Retinal fundus photograph, 2212x1659, 45-degree field of view — 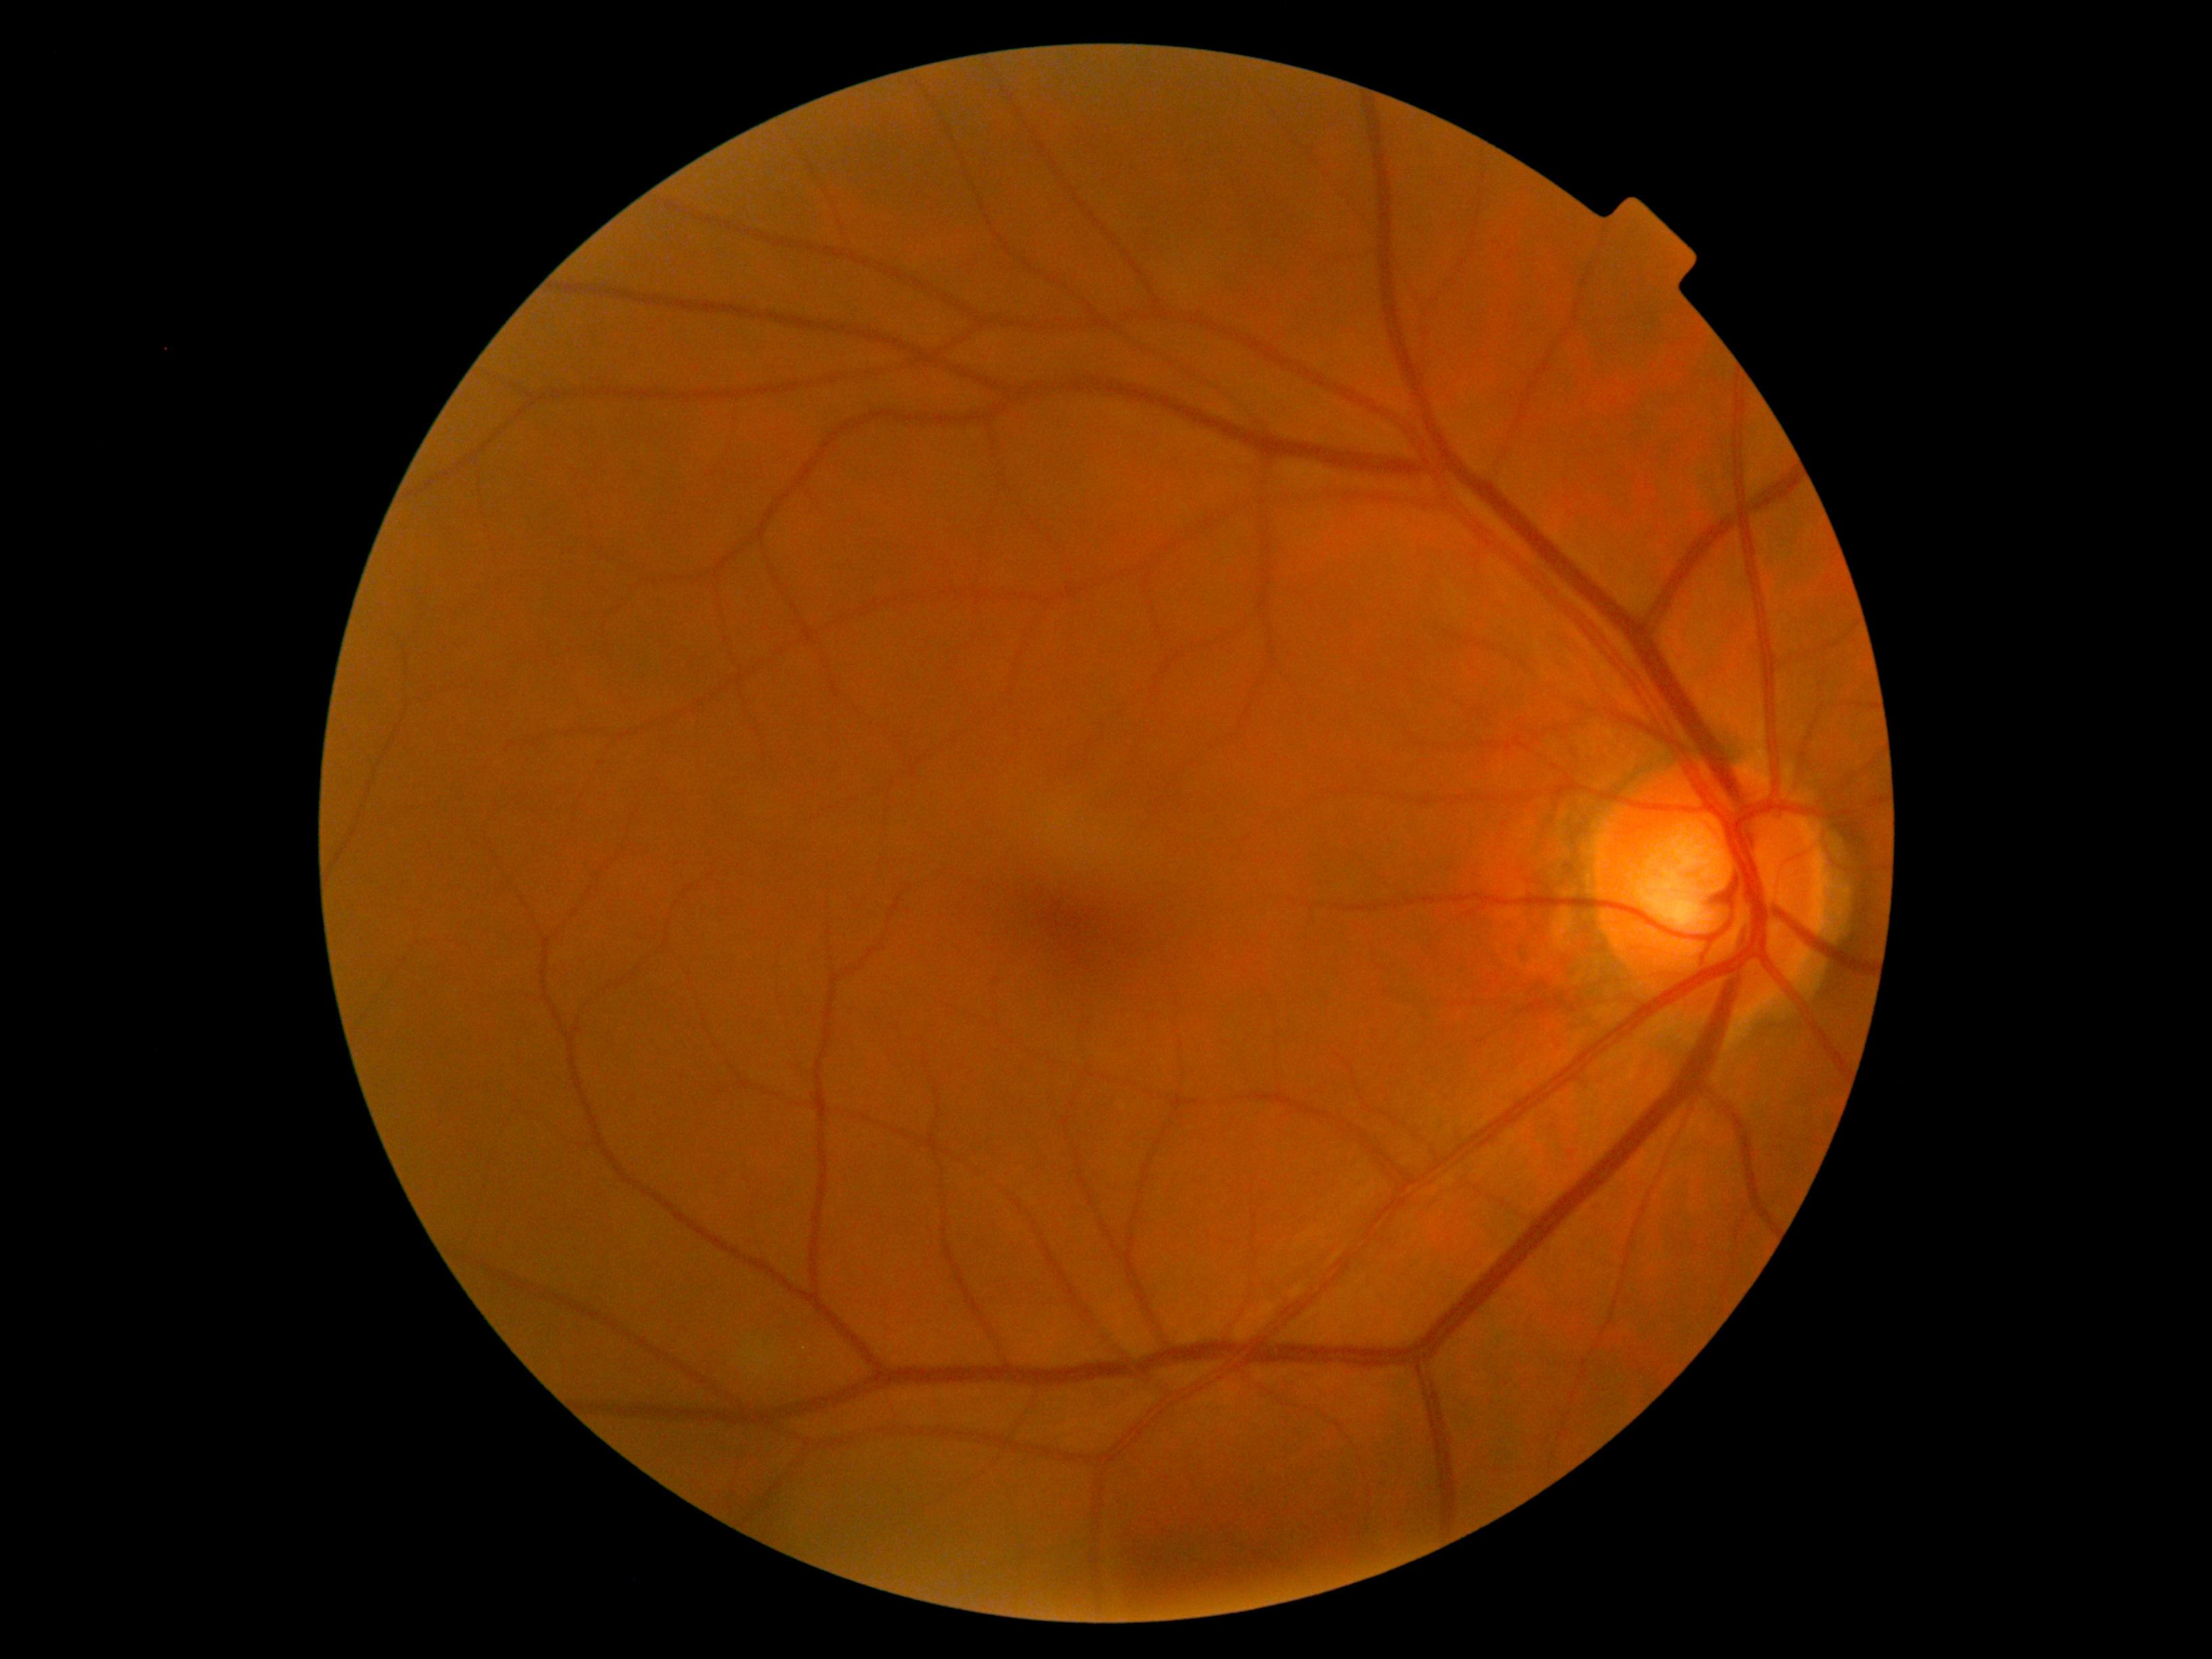

No DR findings. Retinopathy grade is 0.